Modified Davis grading — 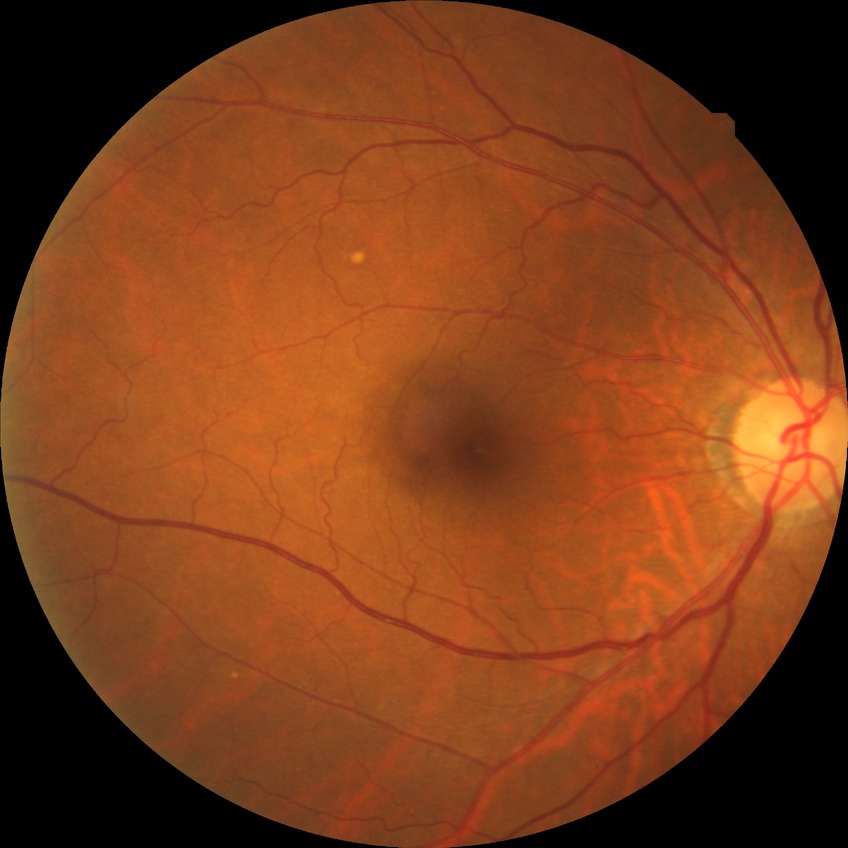 Modified Davis grading: no diabetic retinopathy.